45 degree fundus photograph
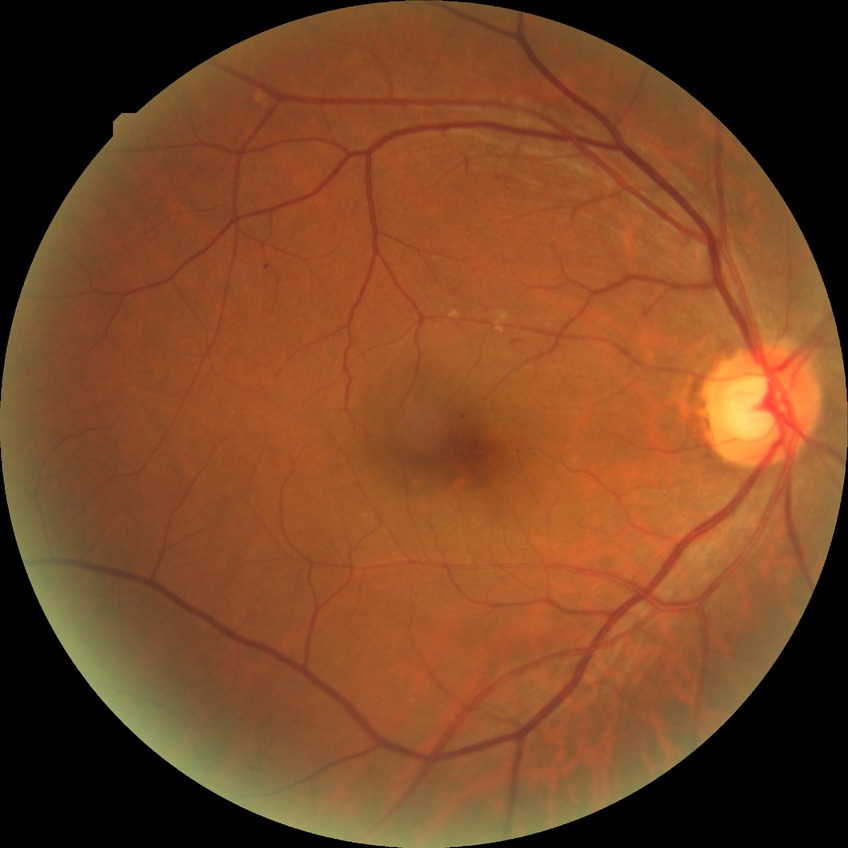 {"davis_grade": "simple diabetic retinopathy (SDR)"}